Wide-field contact fundus photograph of an infant · 640x480: 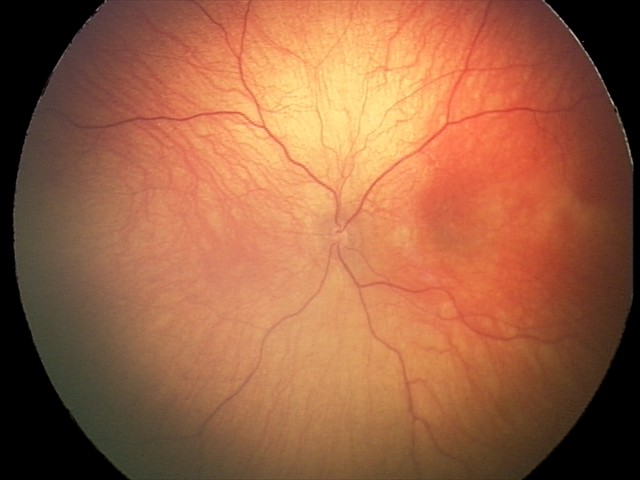 Diagnosis from this screening exam: optic nerve hypoplasia.